NIDEK AFC-230, retinal fundus photograph:
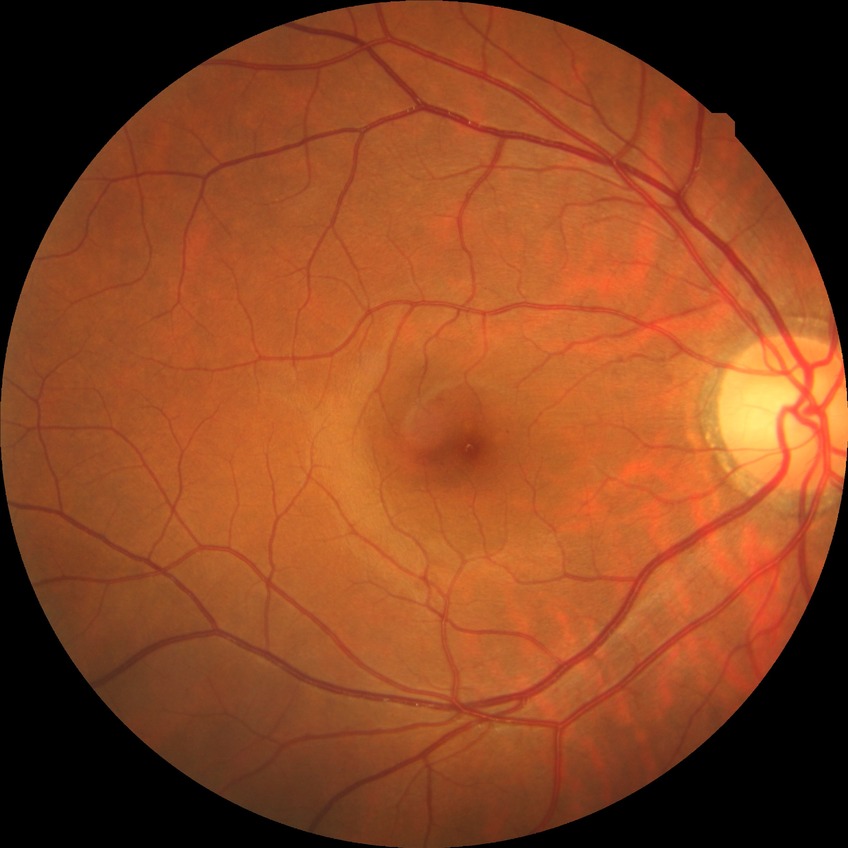

Diabetic retinopathy severity: no diabetic retinopathy.